Modified Davis grading — 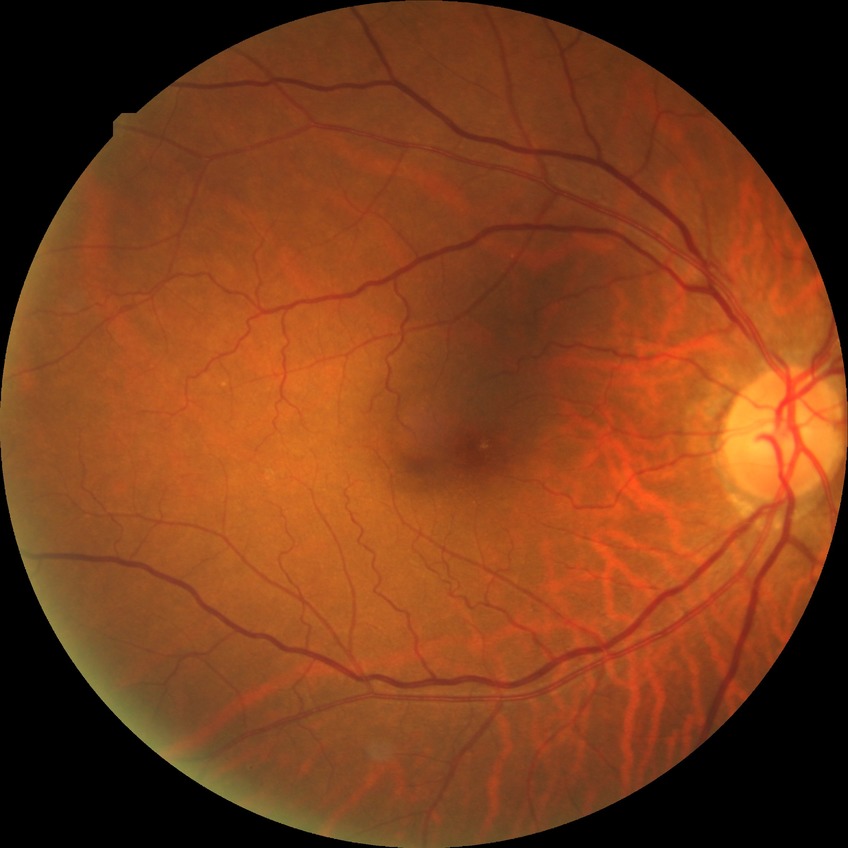 Diabetic retinopathy (DR): NDR (no diabetic retinopathy).